45-degree field of view. NIDEK AFC-230 fundus camera.
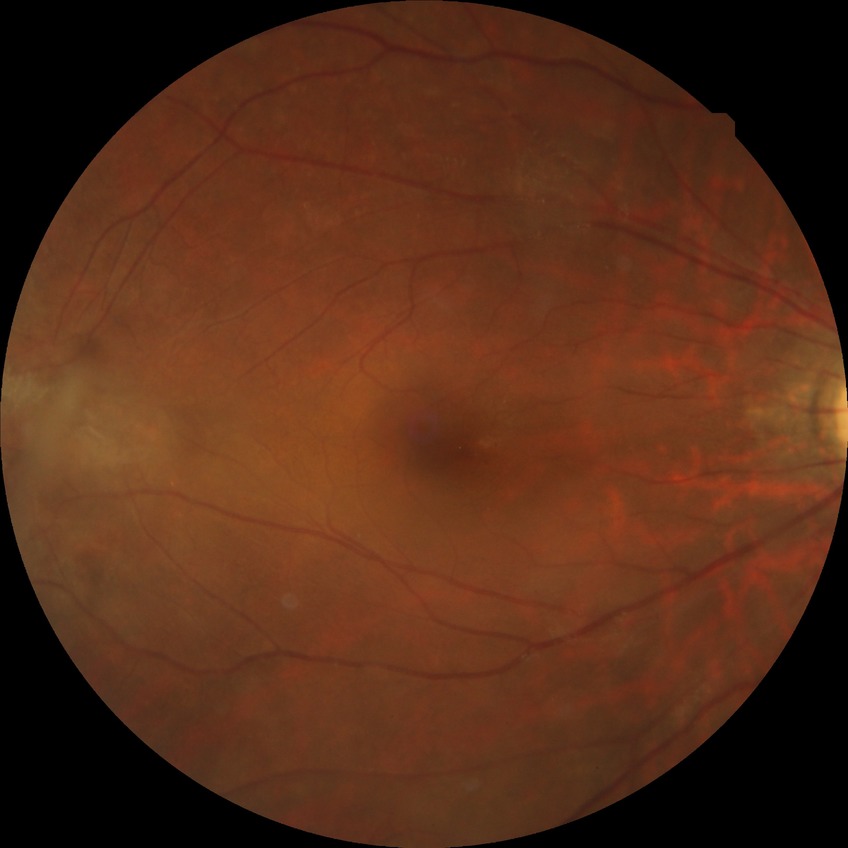
{"davis_grade": "no diabetic retinopathy"}